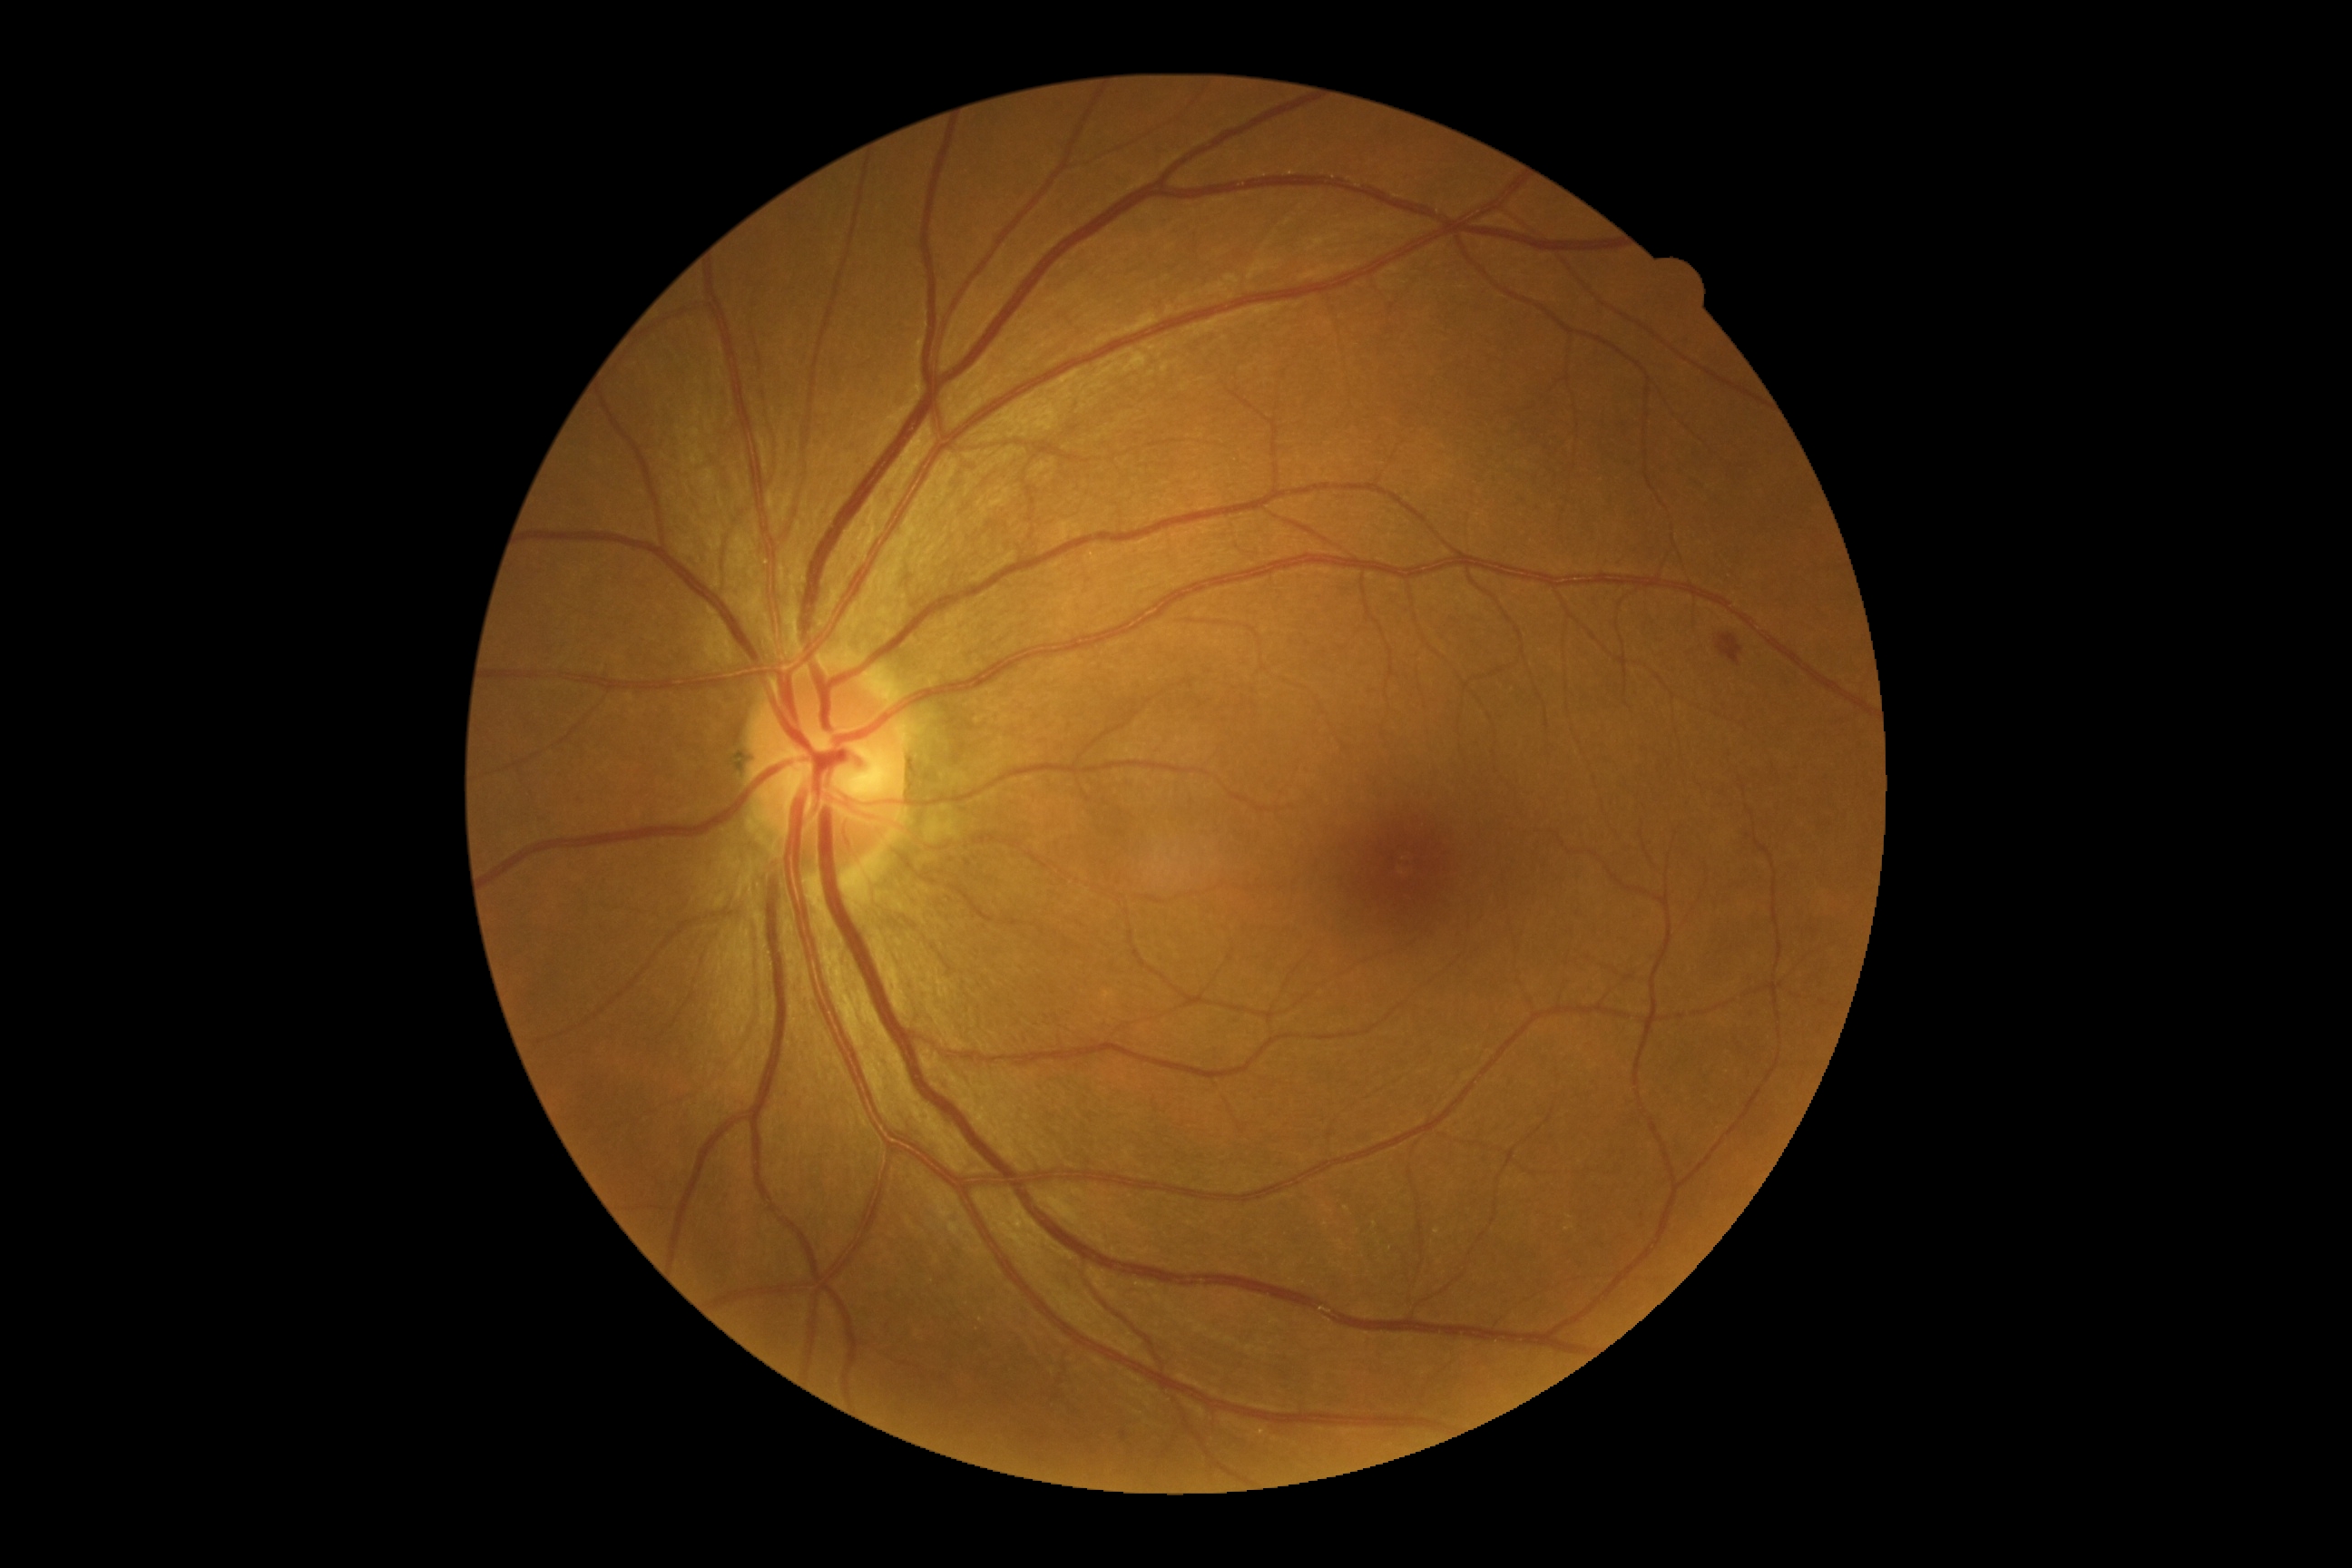
DR class: non-proliferative diabetic retinopathy. Retinopathy grade is moderate non-proliferative diabetic retinopathy (2).